Mydriatic (tropicamide and phenylephrine):
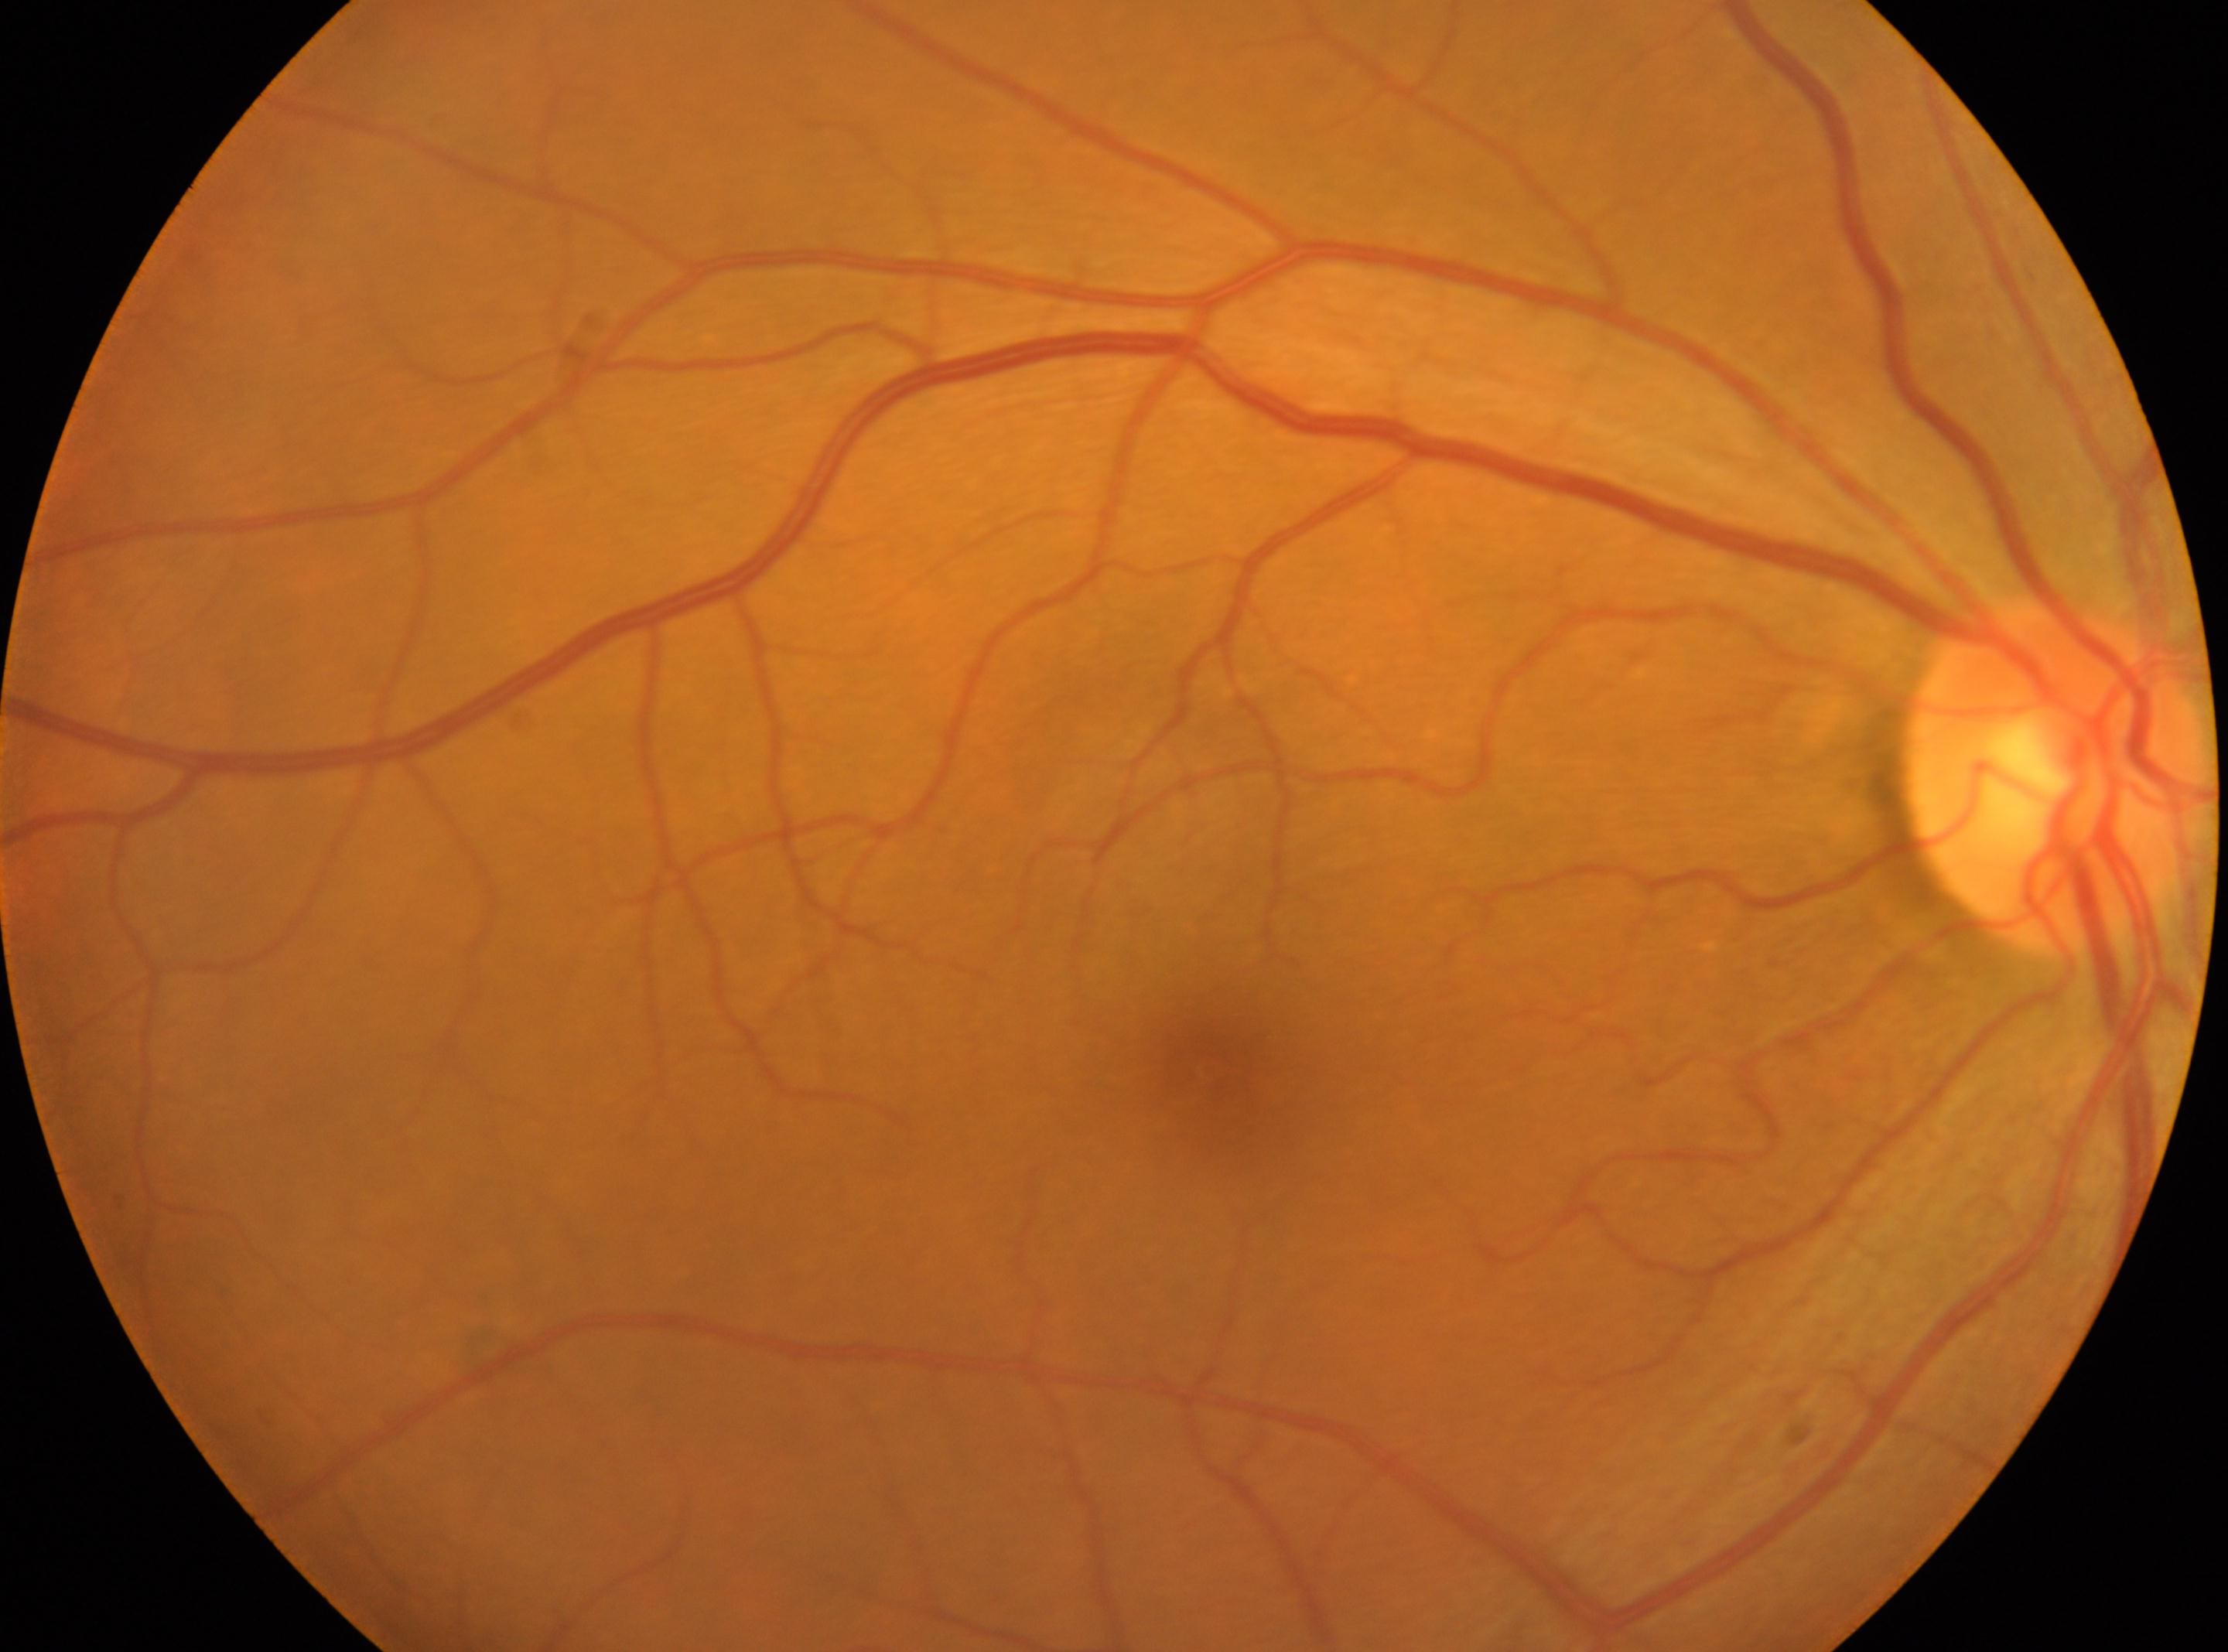 Diabetic retinopathy grade is 0/4. This is the oculus dexter. The optic disc center is at x=2053, y=772. Macular center: x=1210, y=1069.